Color fundus image. 2212x1659px
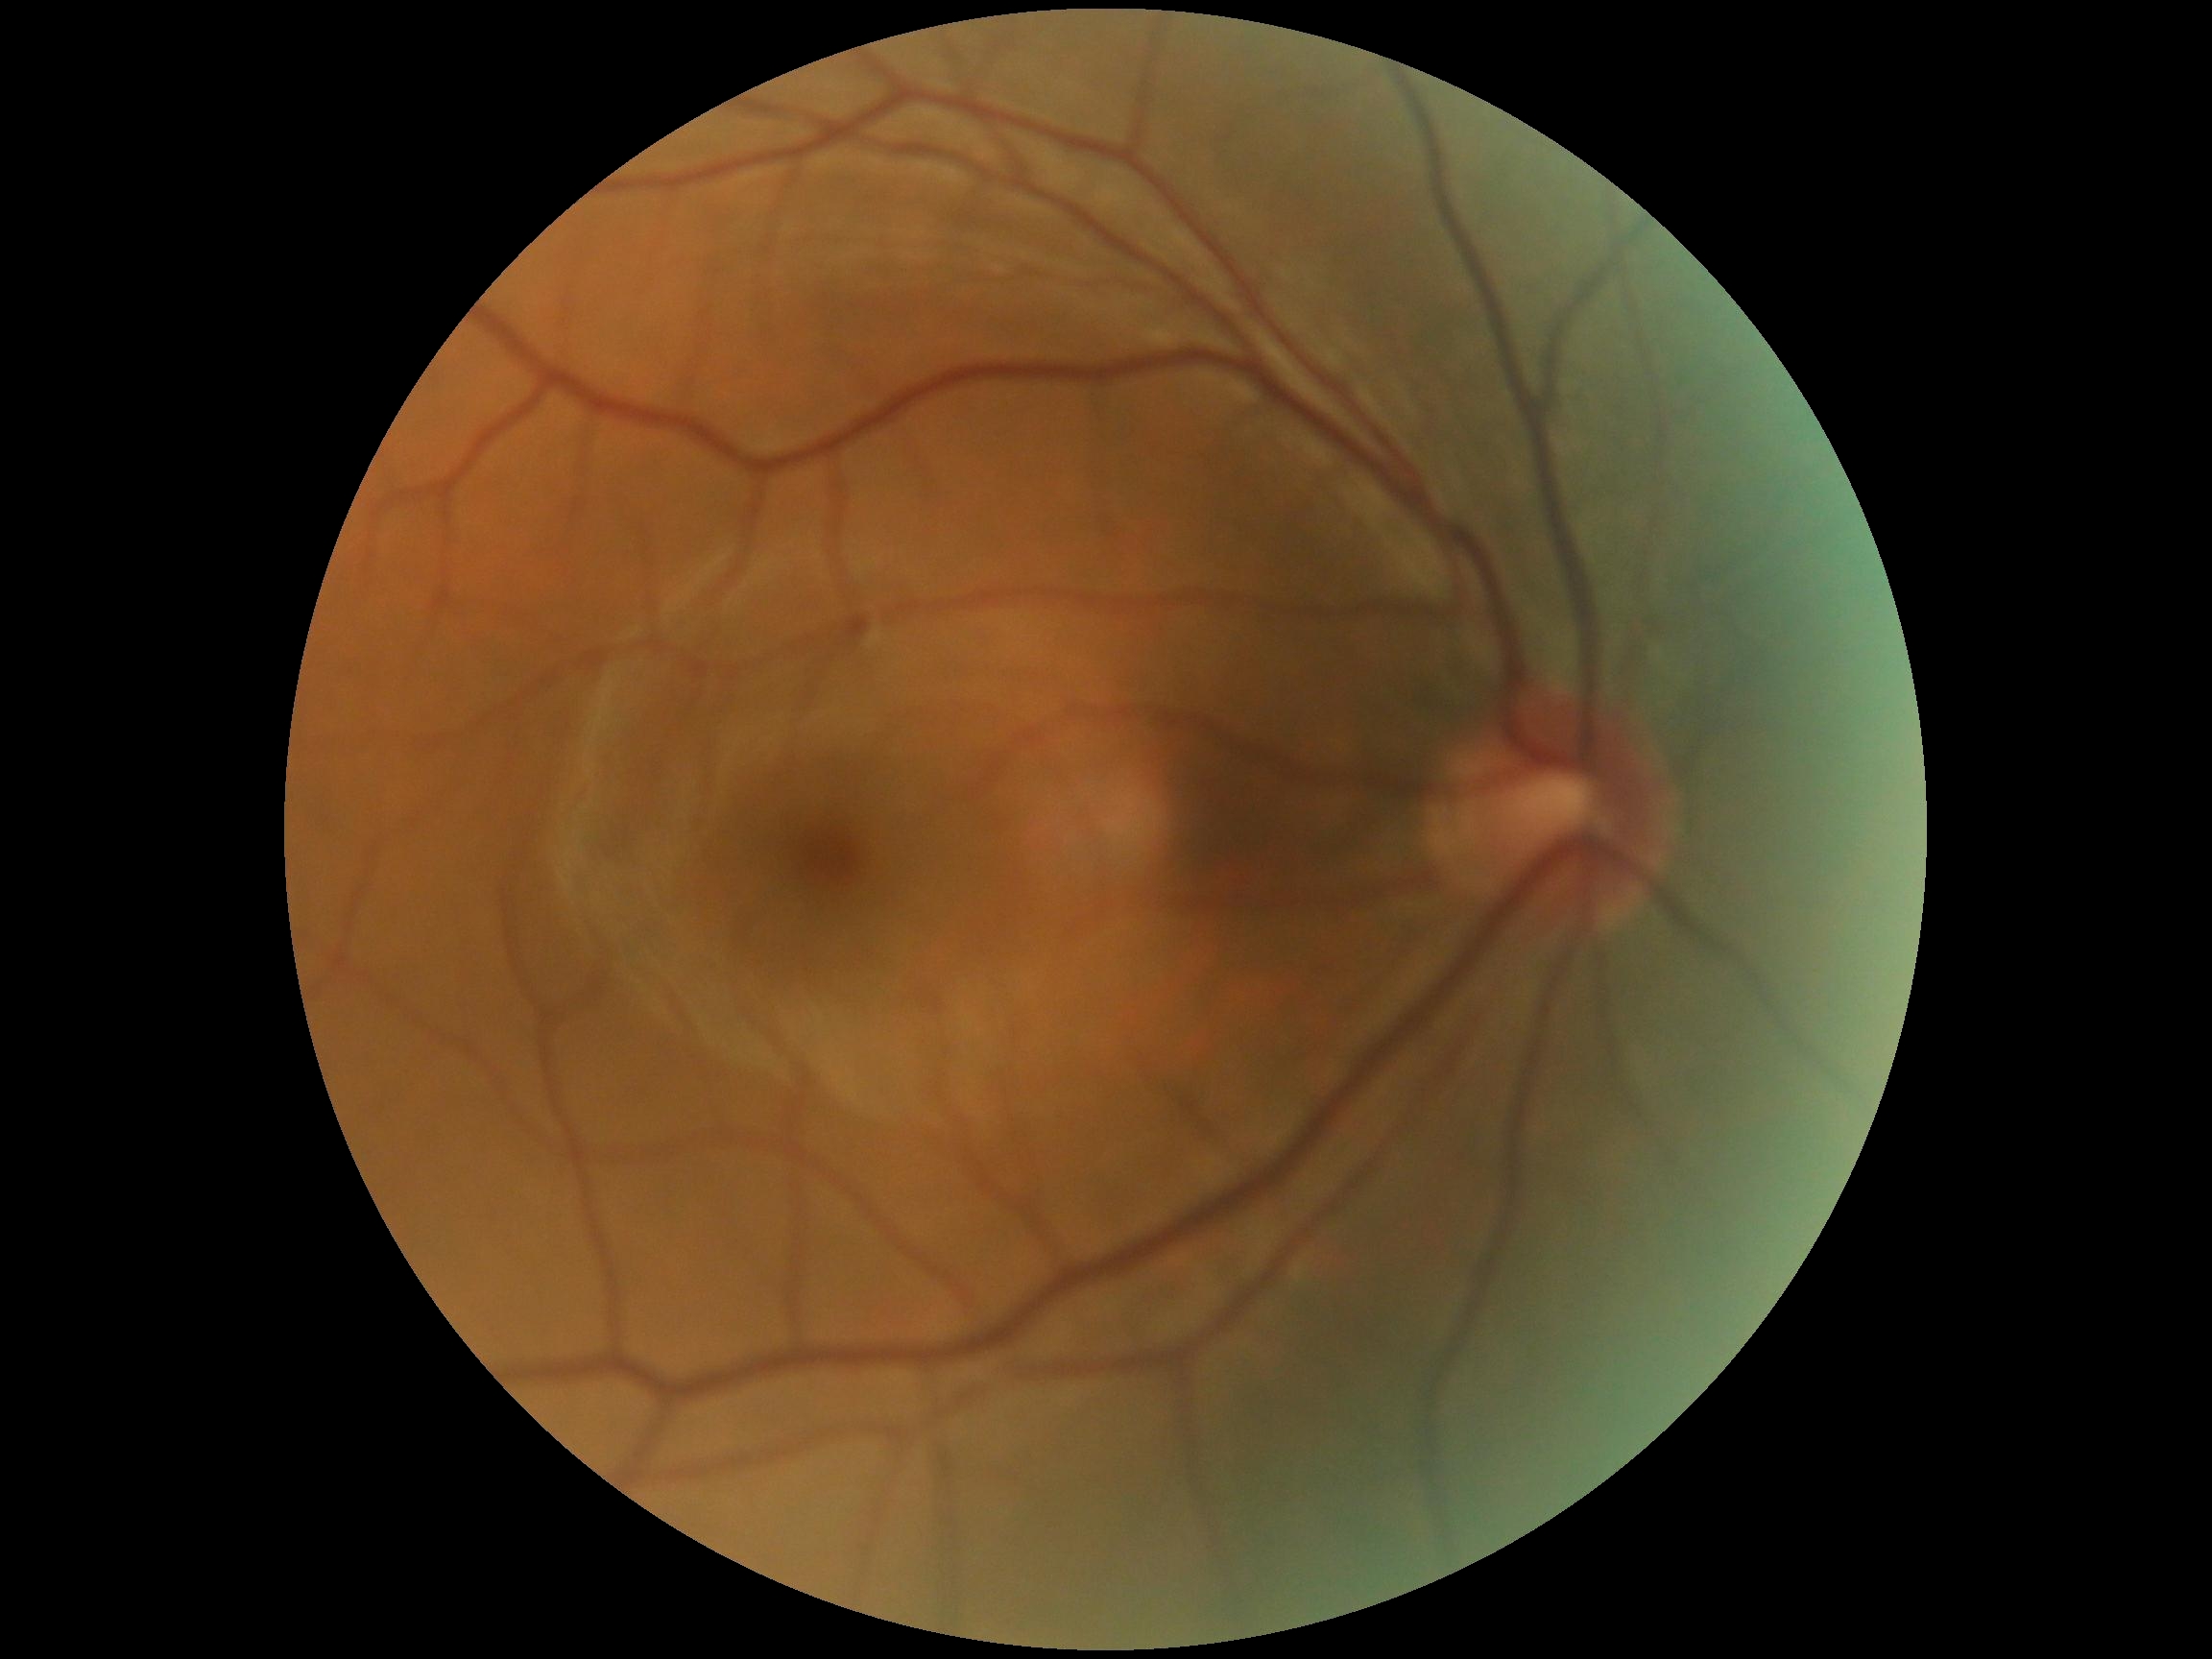 Diabetic retinopathy is 0/4.